848 by 848 pixels: 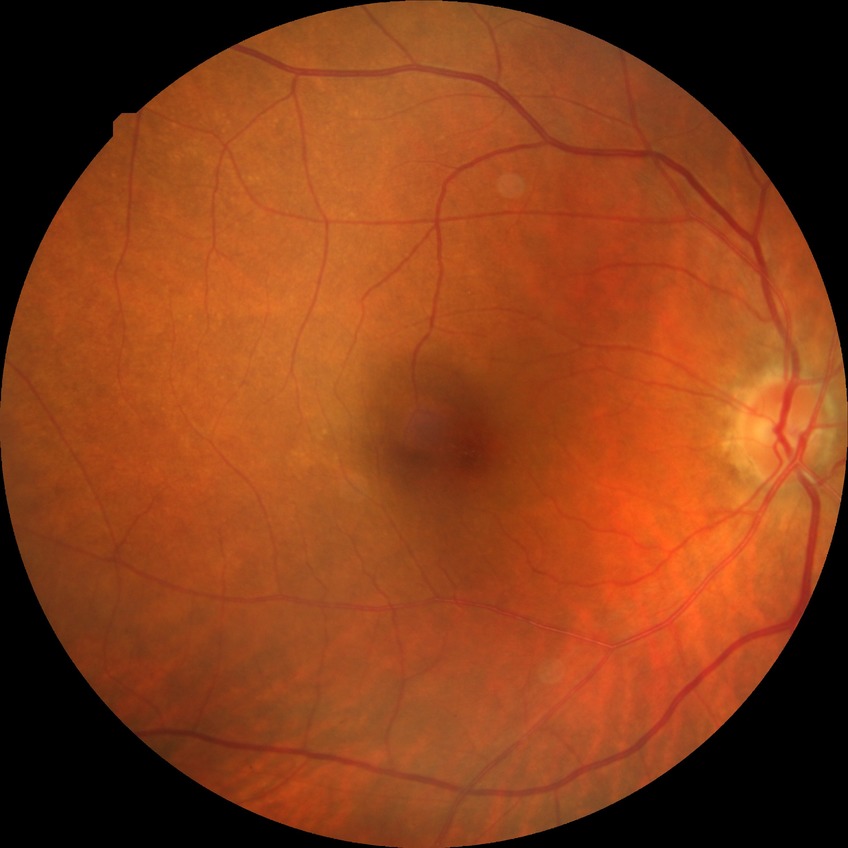

Diabetic retinopathy grade is no diabetic retinopathy.